Image size 640x480. Captured with the Clarity RetCam 3 (130° field of view). Wide-field fundus image from infant ROP screening: 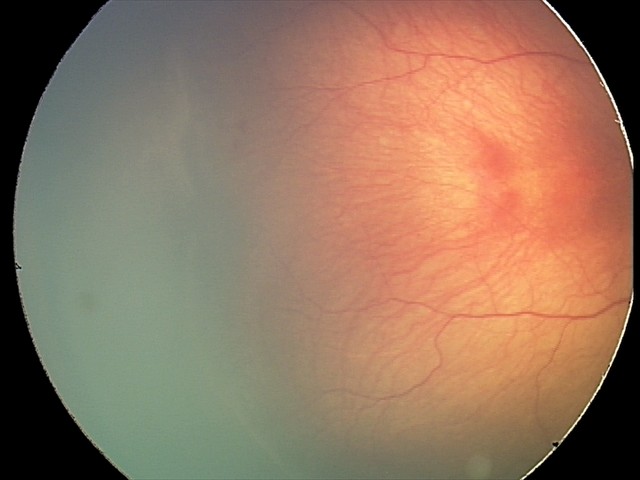 Plus form = absent; diagnosis = ROP stage 2.